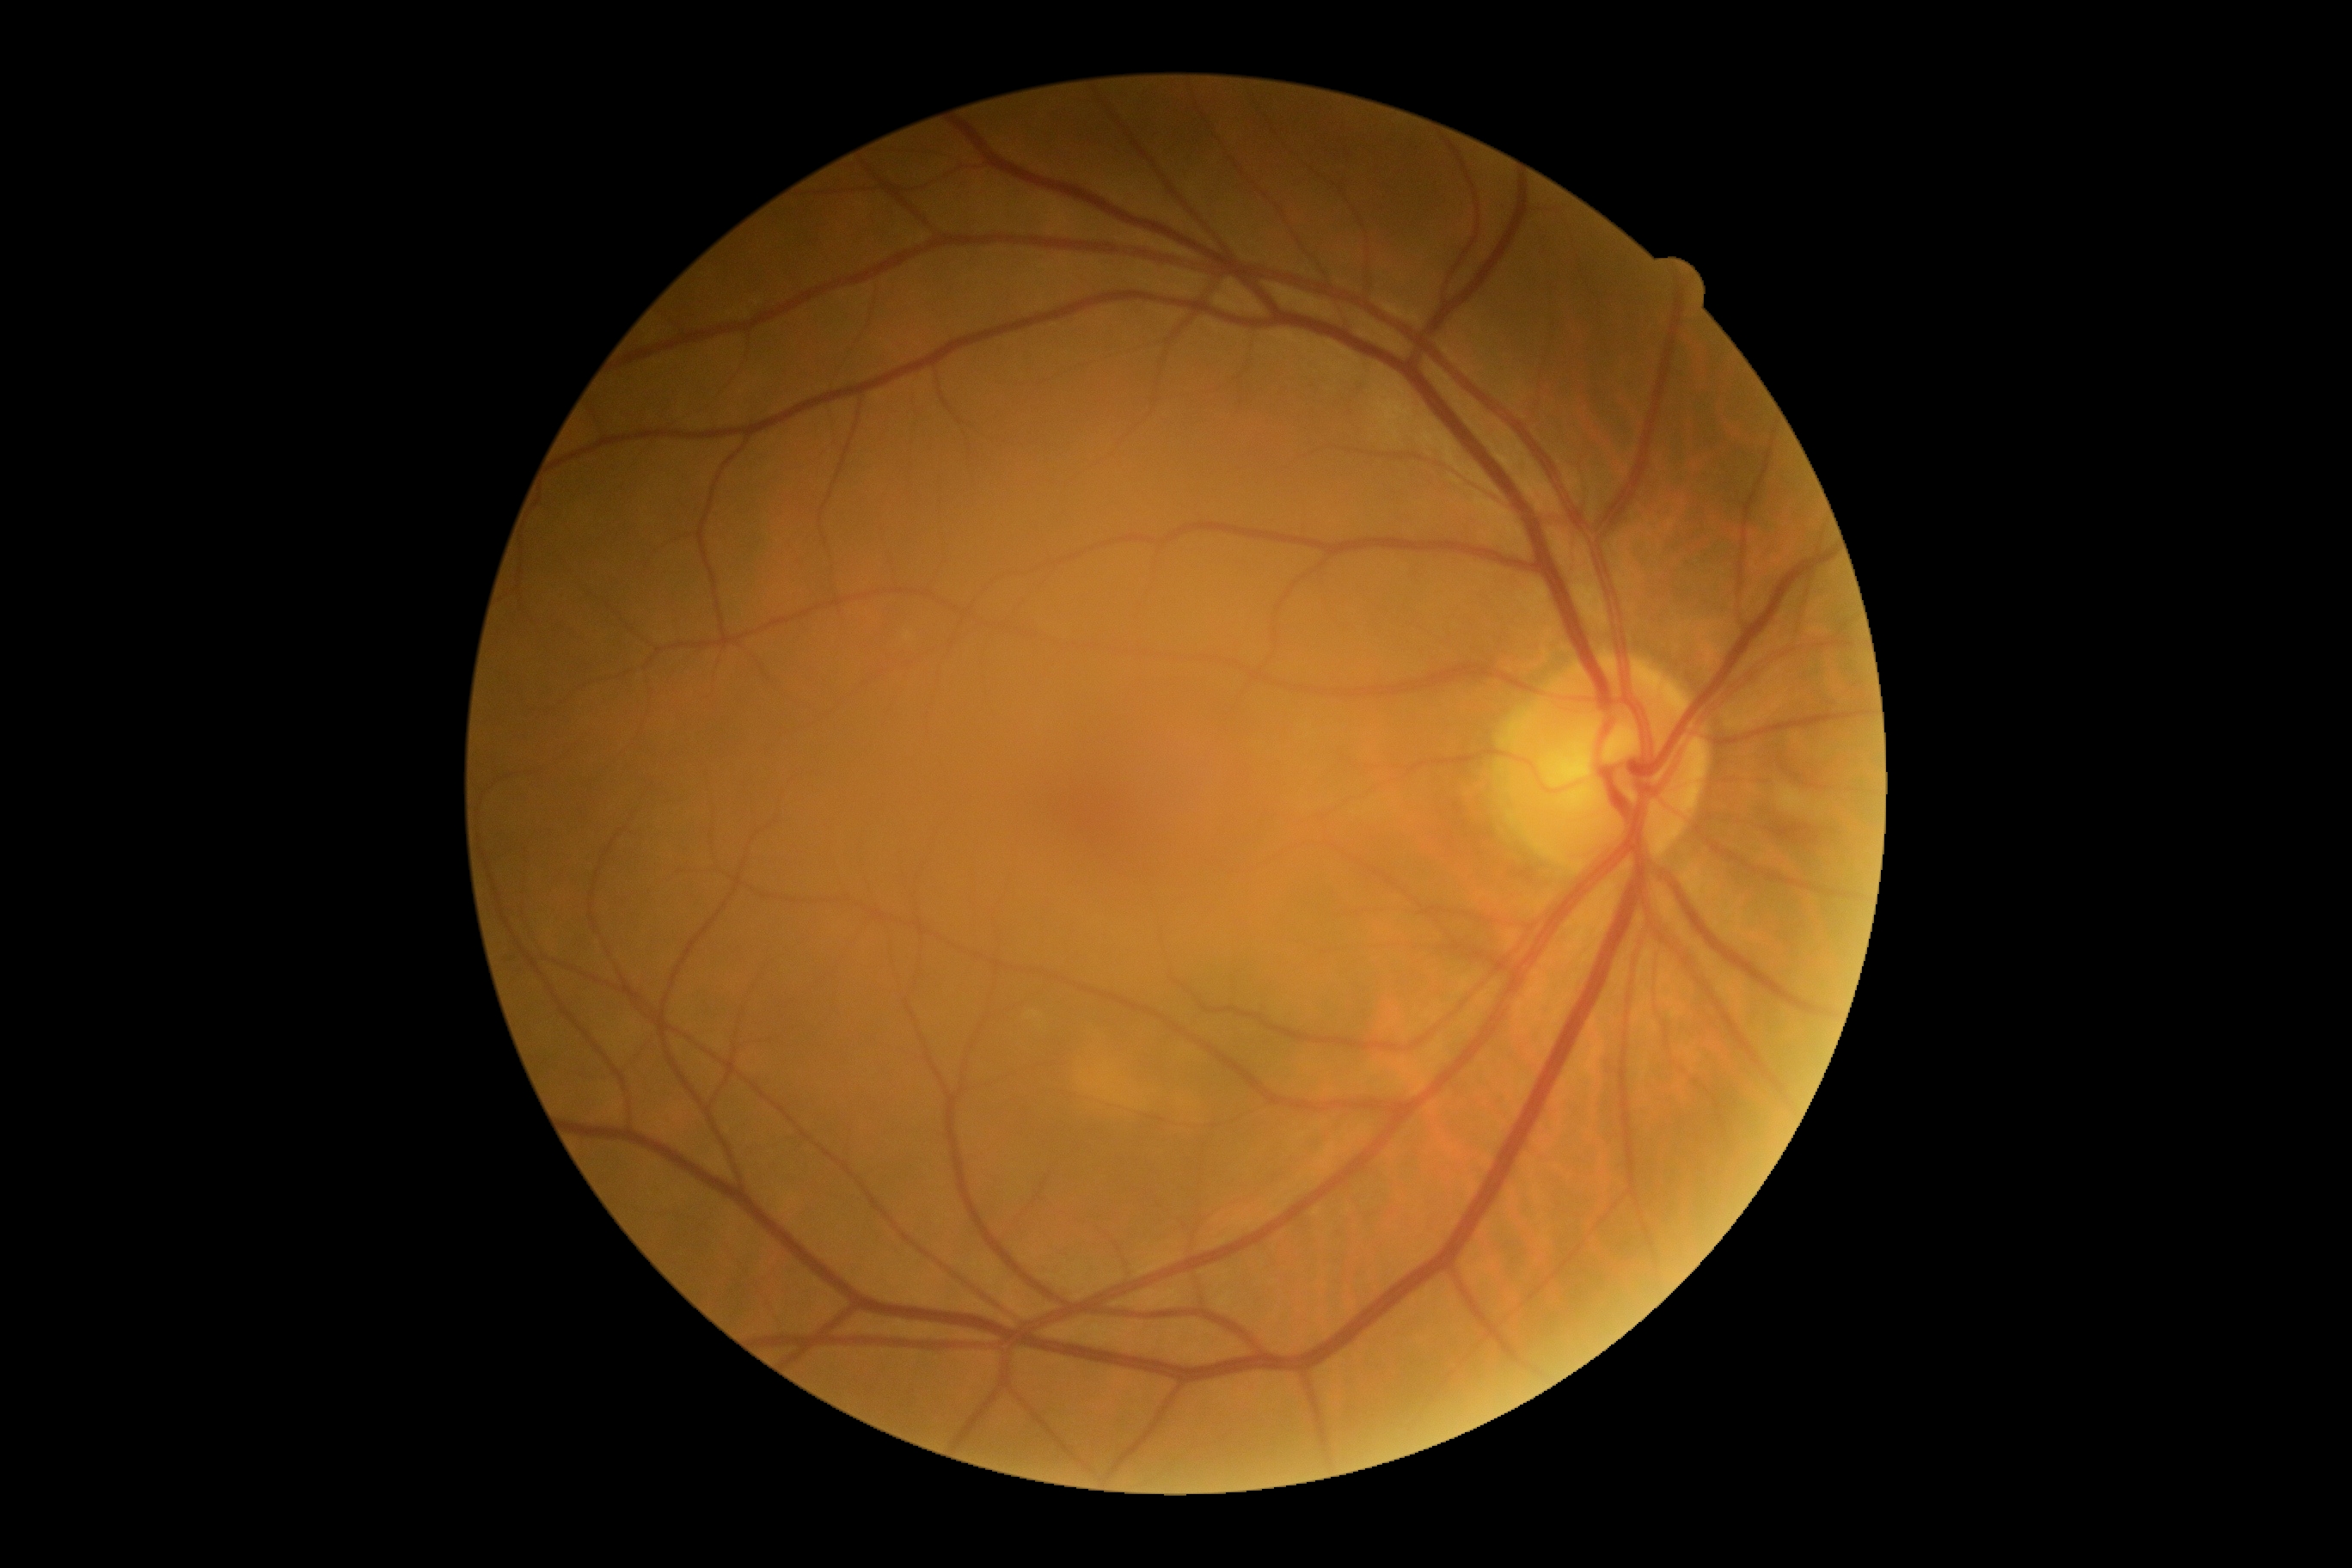
– DR impression — no DR findings
– diabetic retinopathy (DR) — grade 0 — no visible signs of diabetic retinopathy